Camera: Topcon TRC-50DX. Dilated-pupil acquisition. 50-degree field of view — 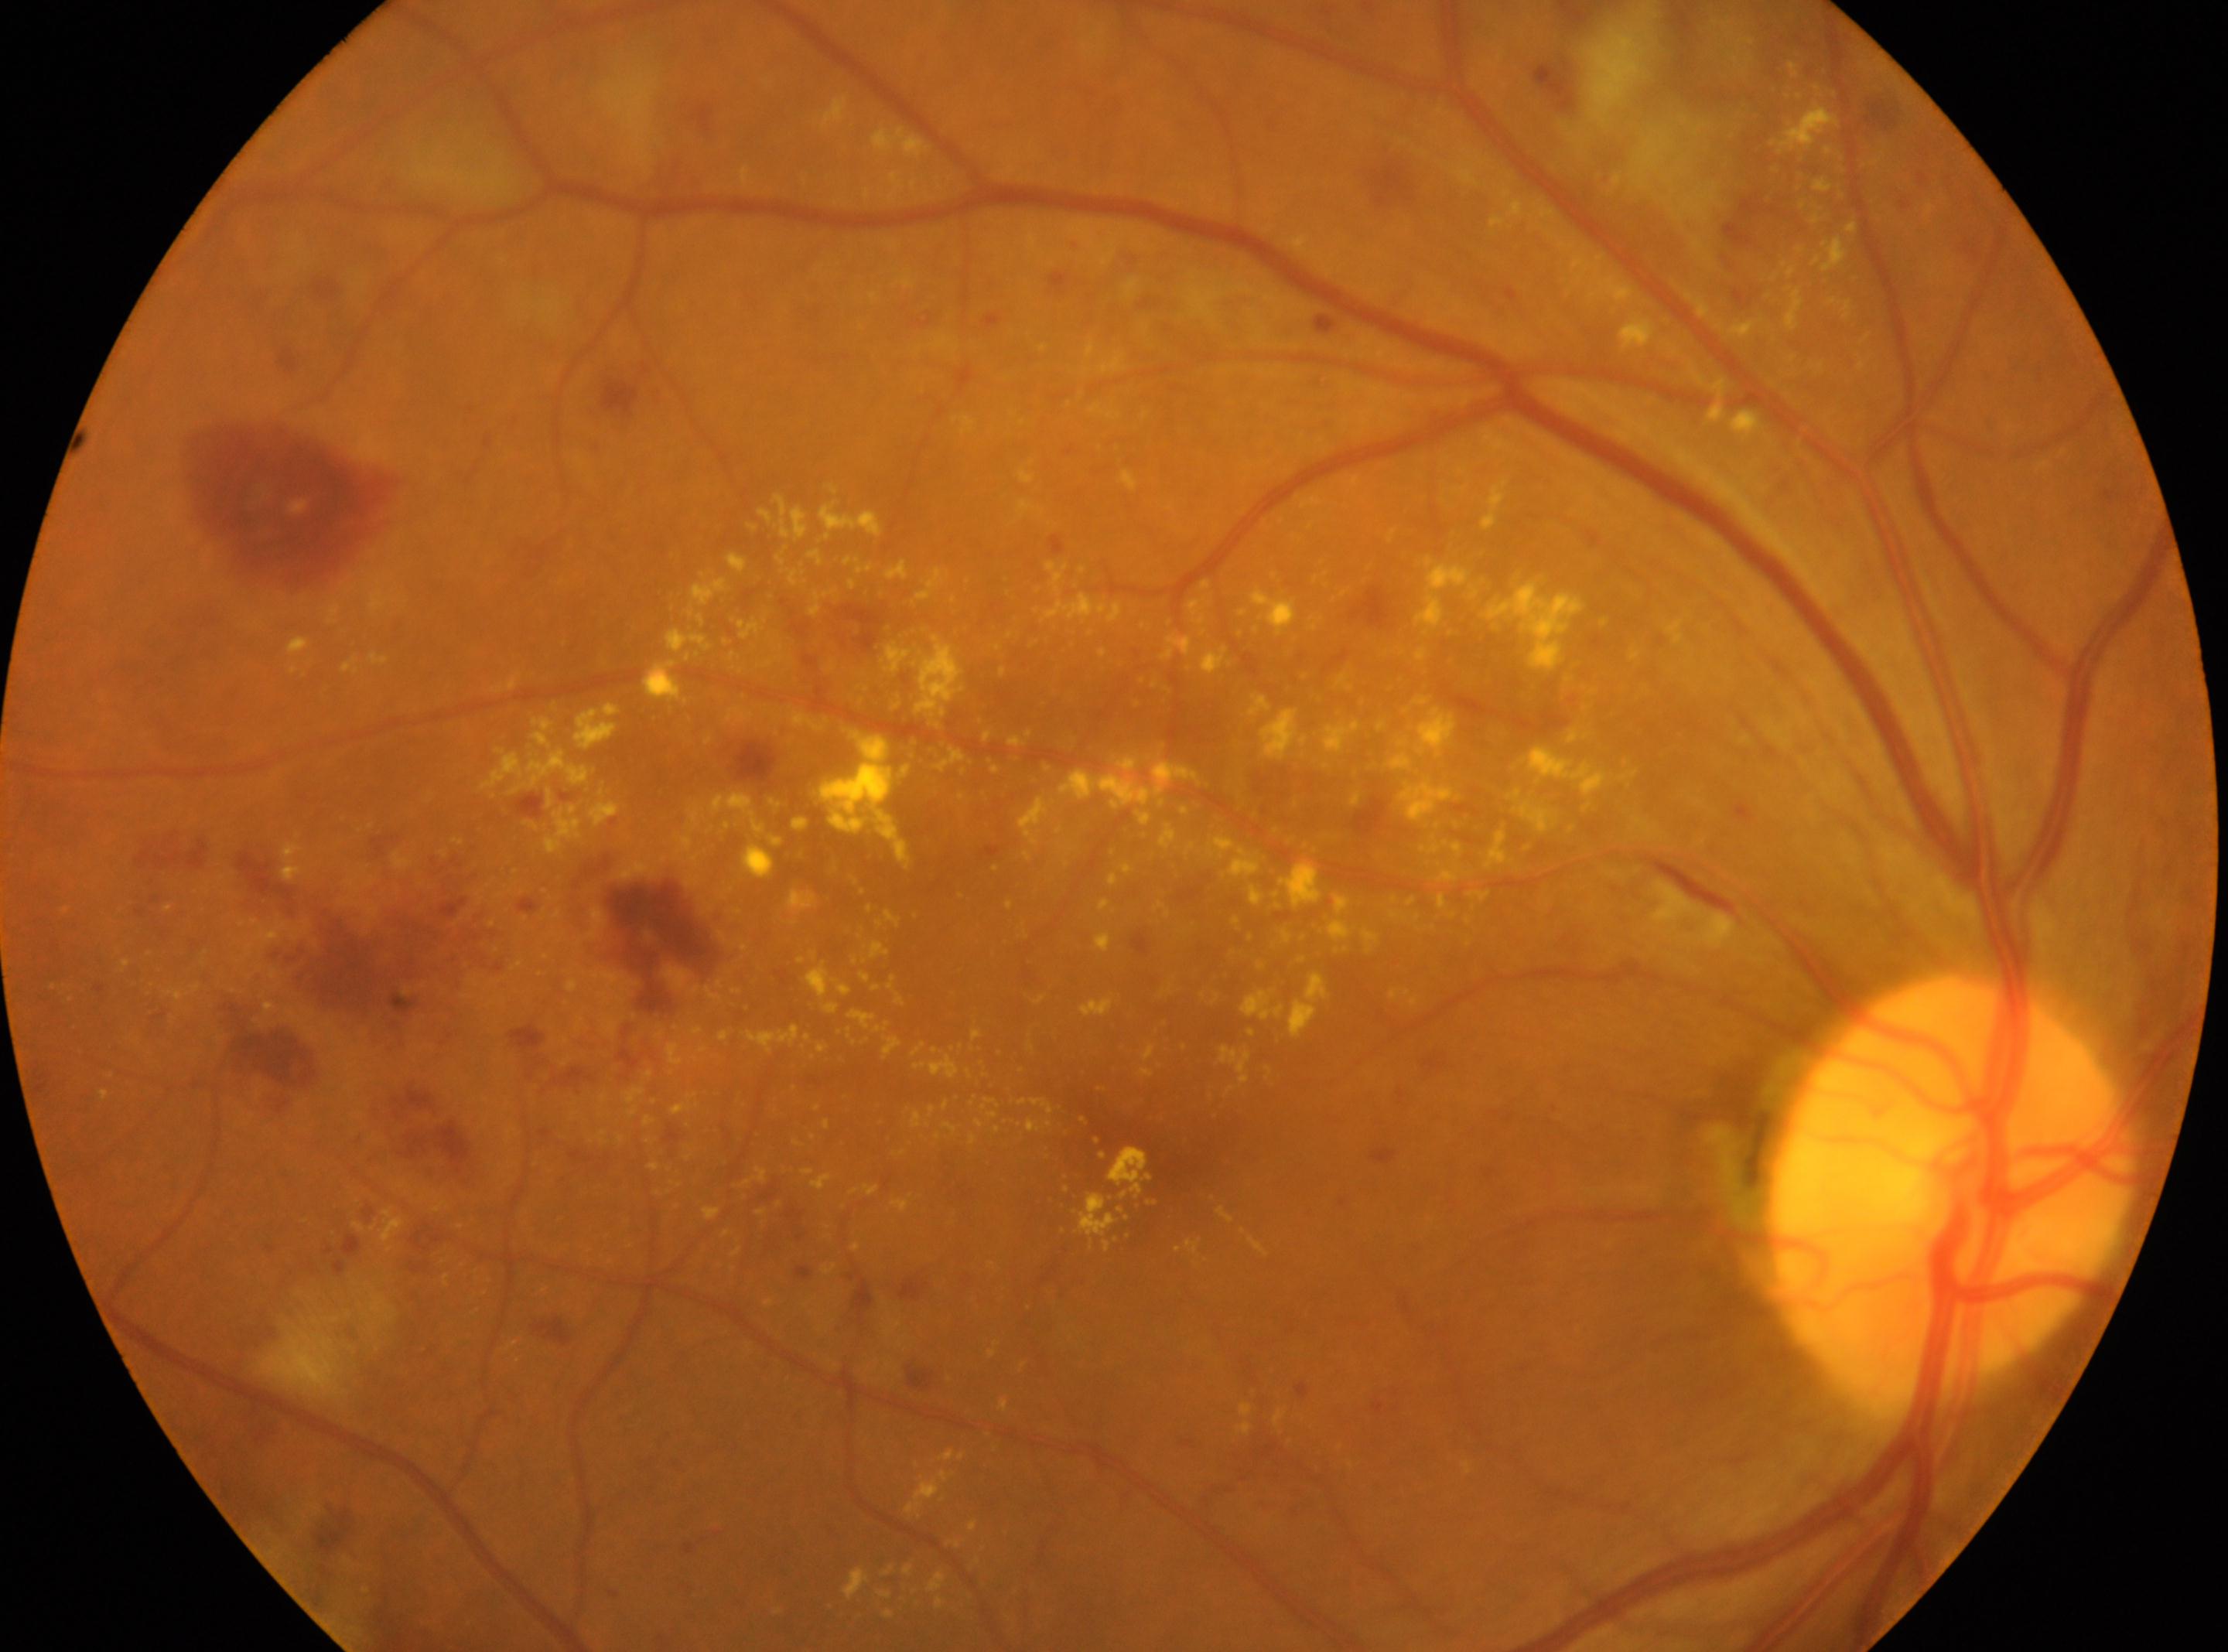
eye = OD; optic nerve head = 1950px, 1183px; DR severity = 3; the fovea = 1153px, 1145px.